Fundus photo — 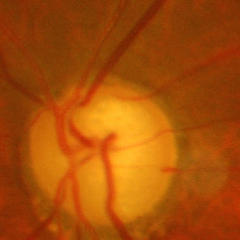

Showing advanced-stage glaucoma.